Pediatric retinal photograph (wide-field).
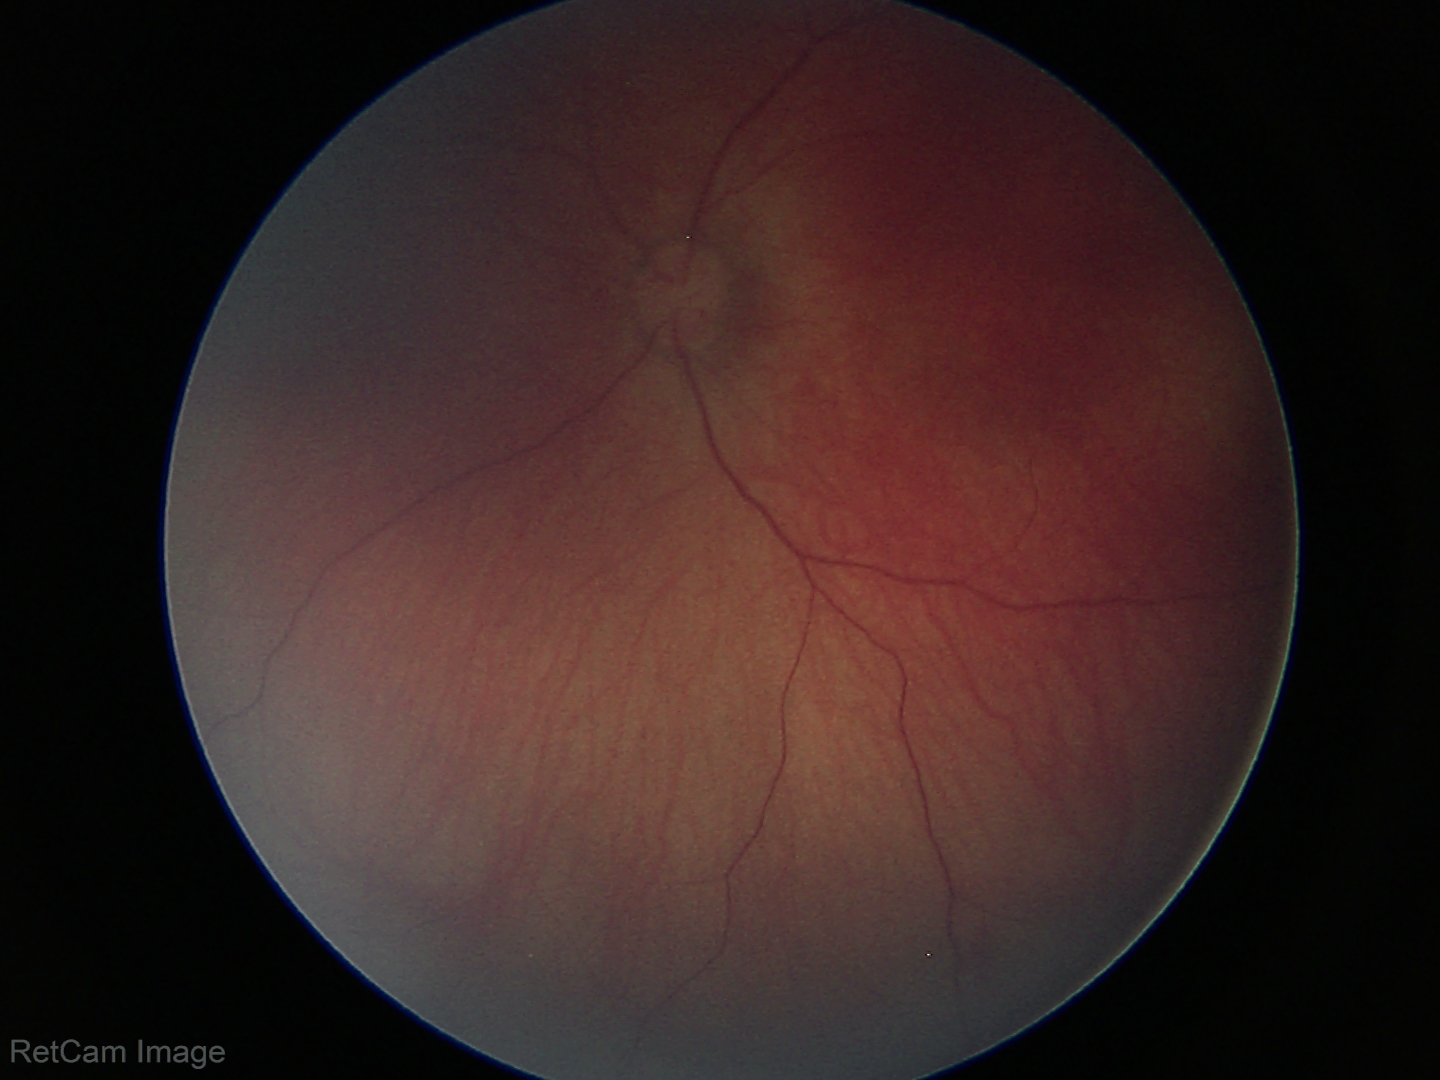 Impression = normal retinal appearance